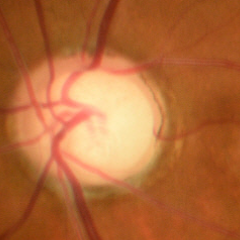

Early glaucoma.